Infant wide-field fundus photograph. 130° field of view (Clarity RetCam 3).
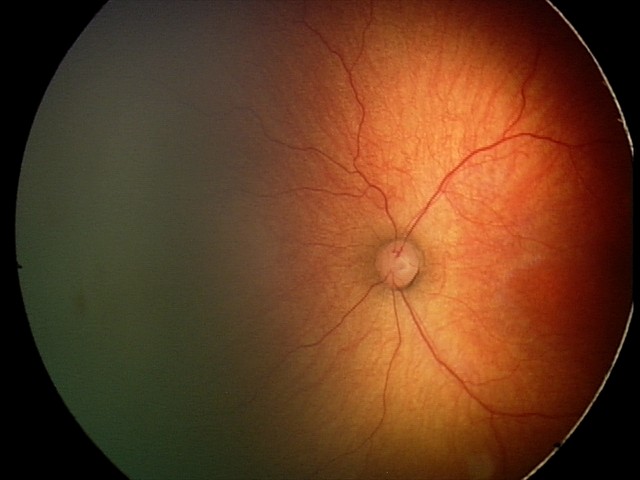 Without plus disease. Diagnosis from this screening exam: retinopathy of prematurity stage 2.